Color fundus image · NIDEK AFC-230.
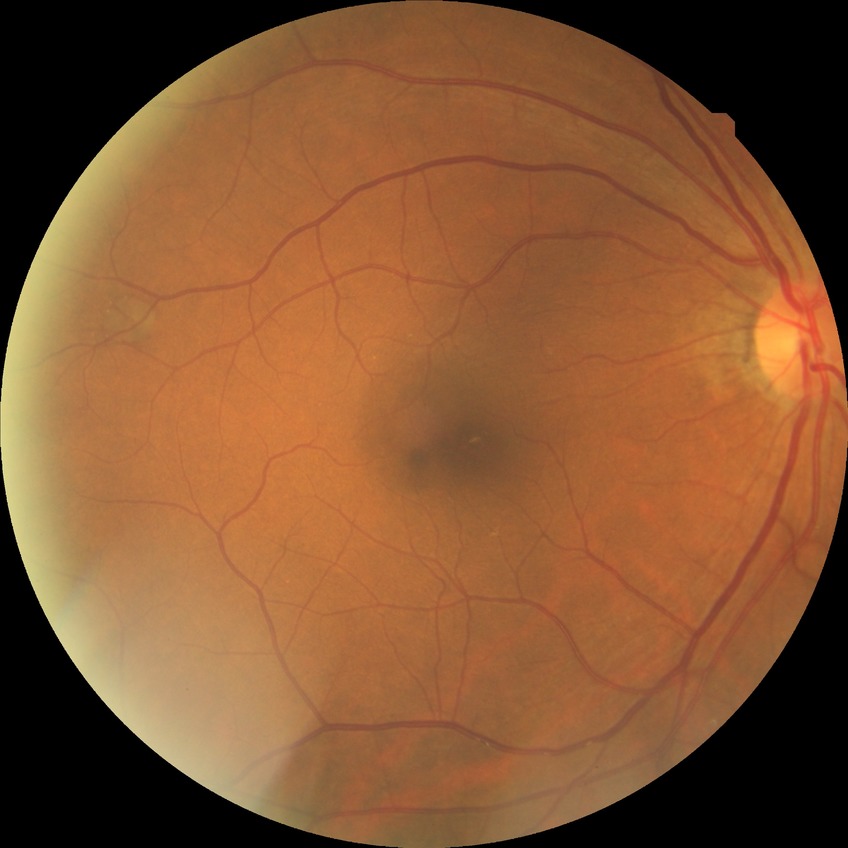

{"davis_grade": "SDR"}